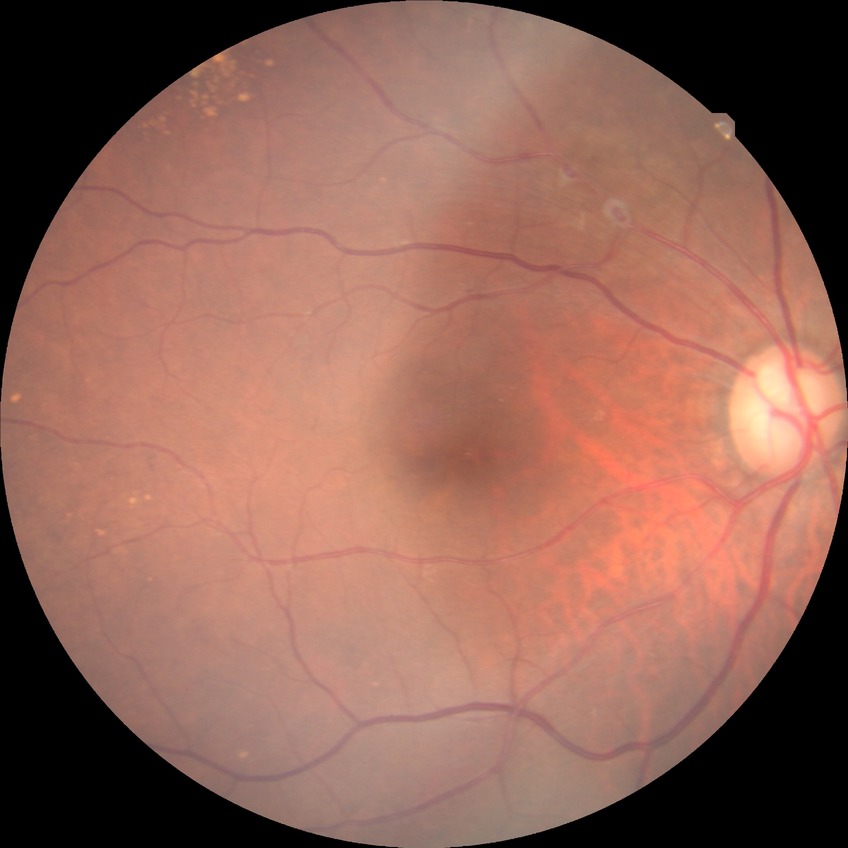 Diabetic retinopathy (DR) is no diabetic retinopathy (NDR).